Disc-centered fundus crop, 35° field of view before cropping, Topcon TRC retinal camera, IMAGEnet capture system: 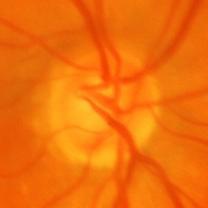 Optic disc appearance consistent with glaucomatous changes.